Color fundus image, 1924 x 1556 pixels
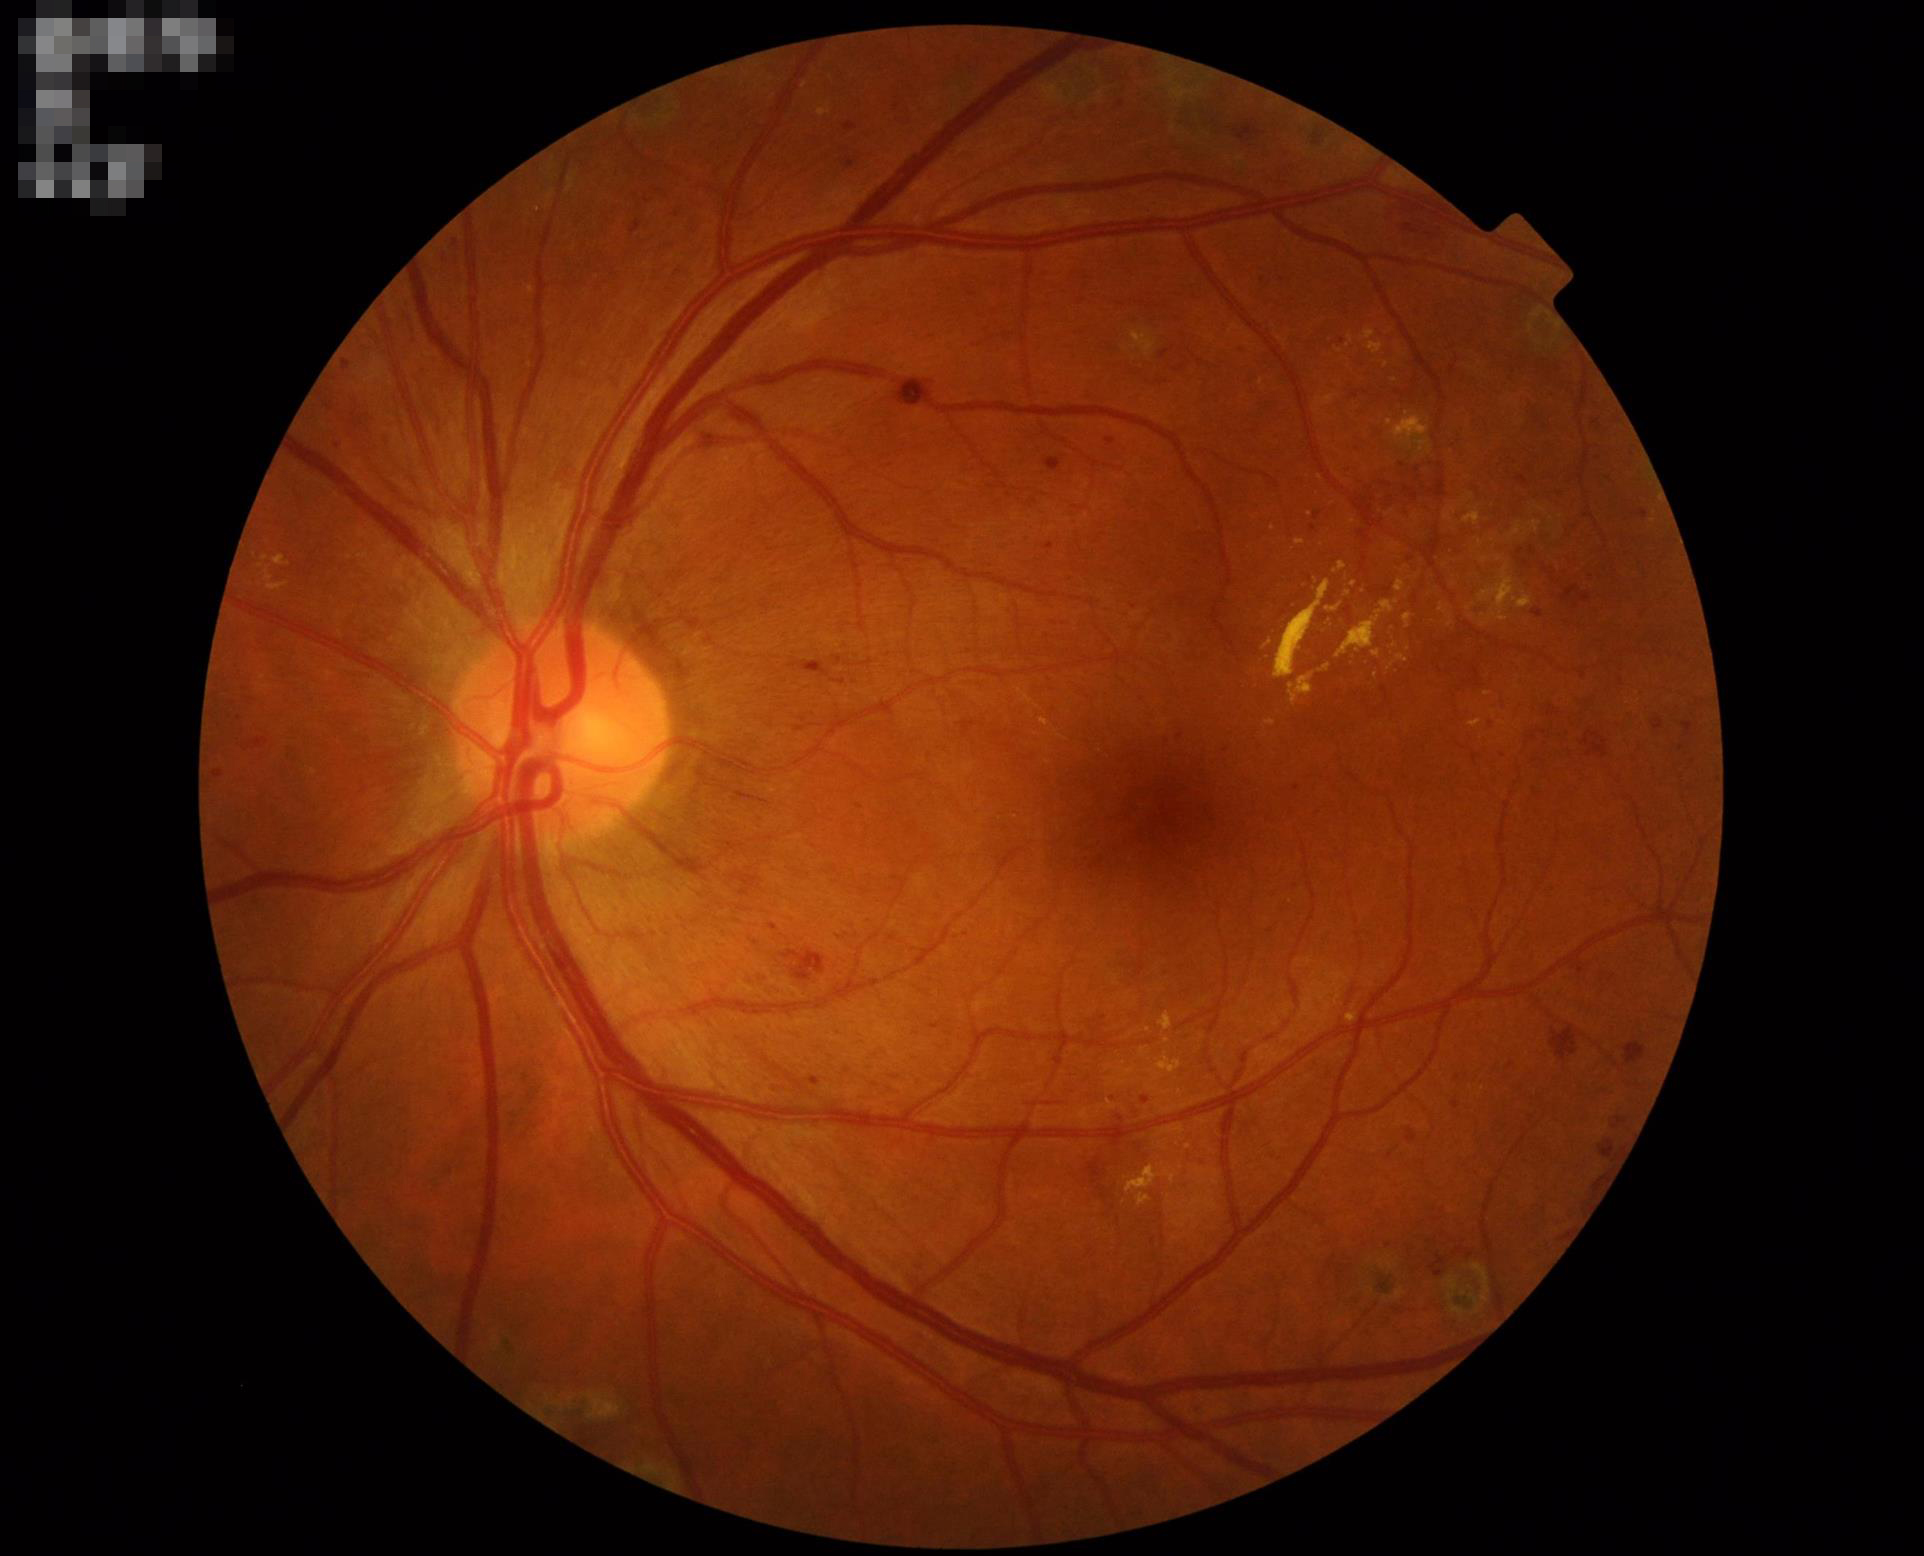
Illumination = good illumination and color balance; Overall image quality = good, gradable; Contrast = good dynamic range; Focus = clear with no noticeable blur.